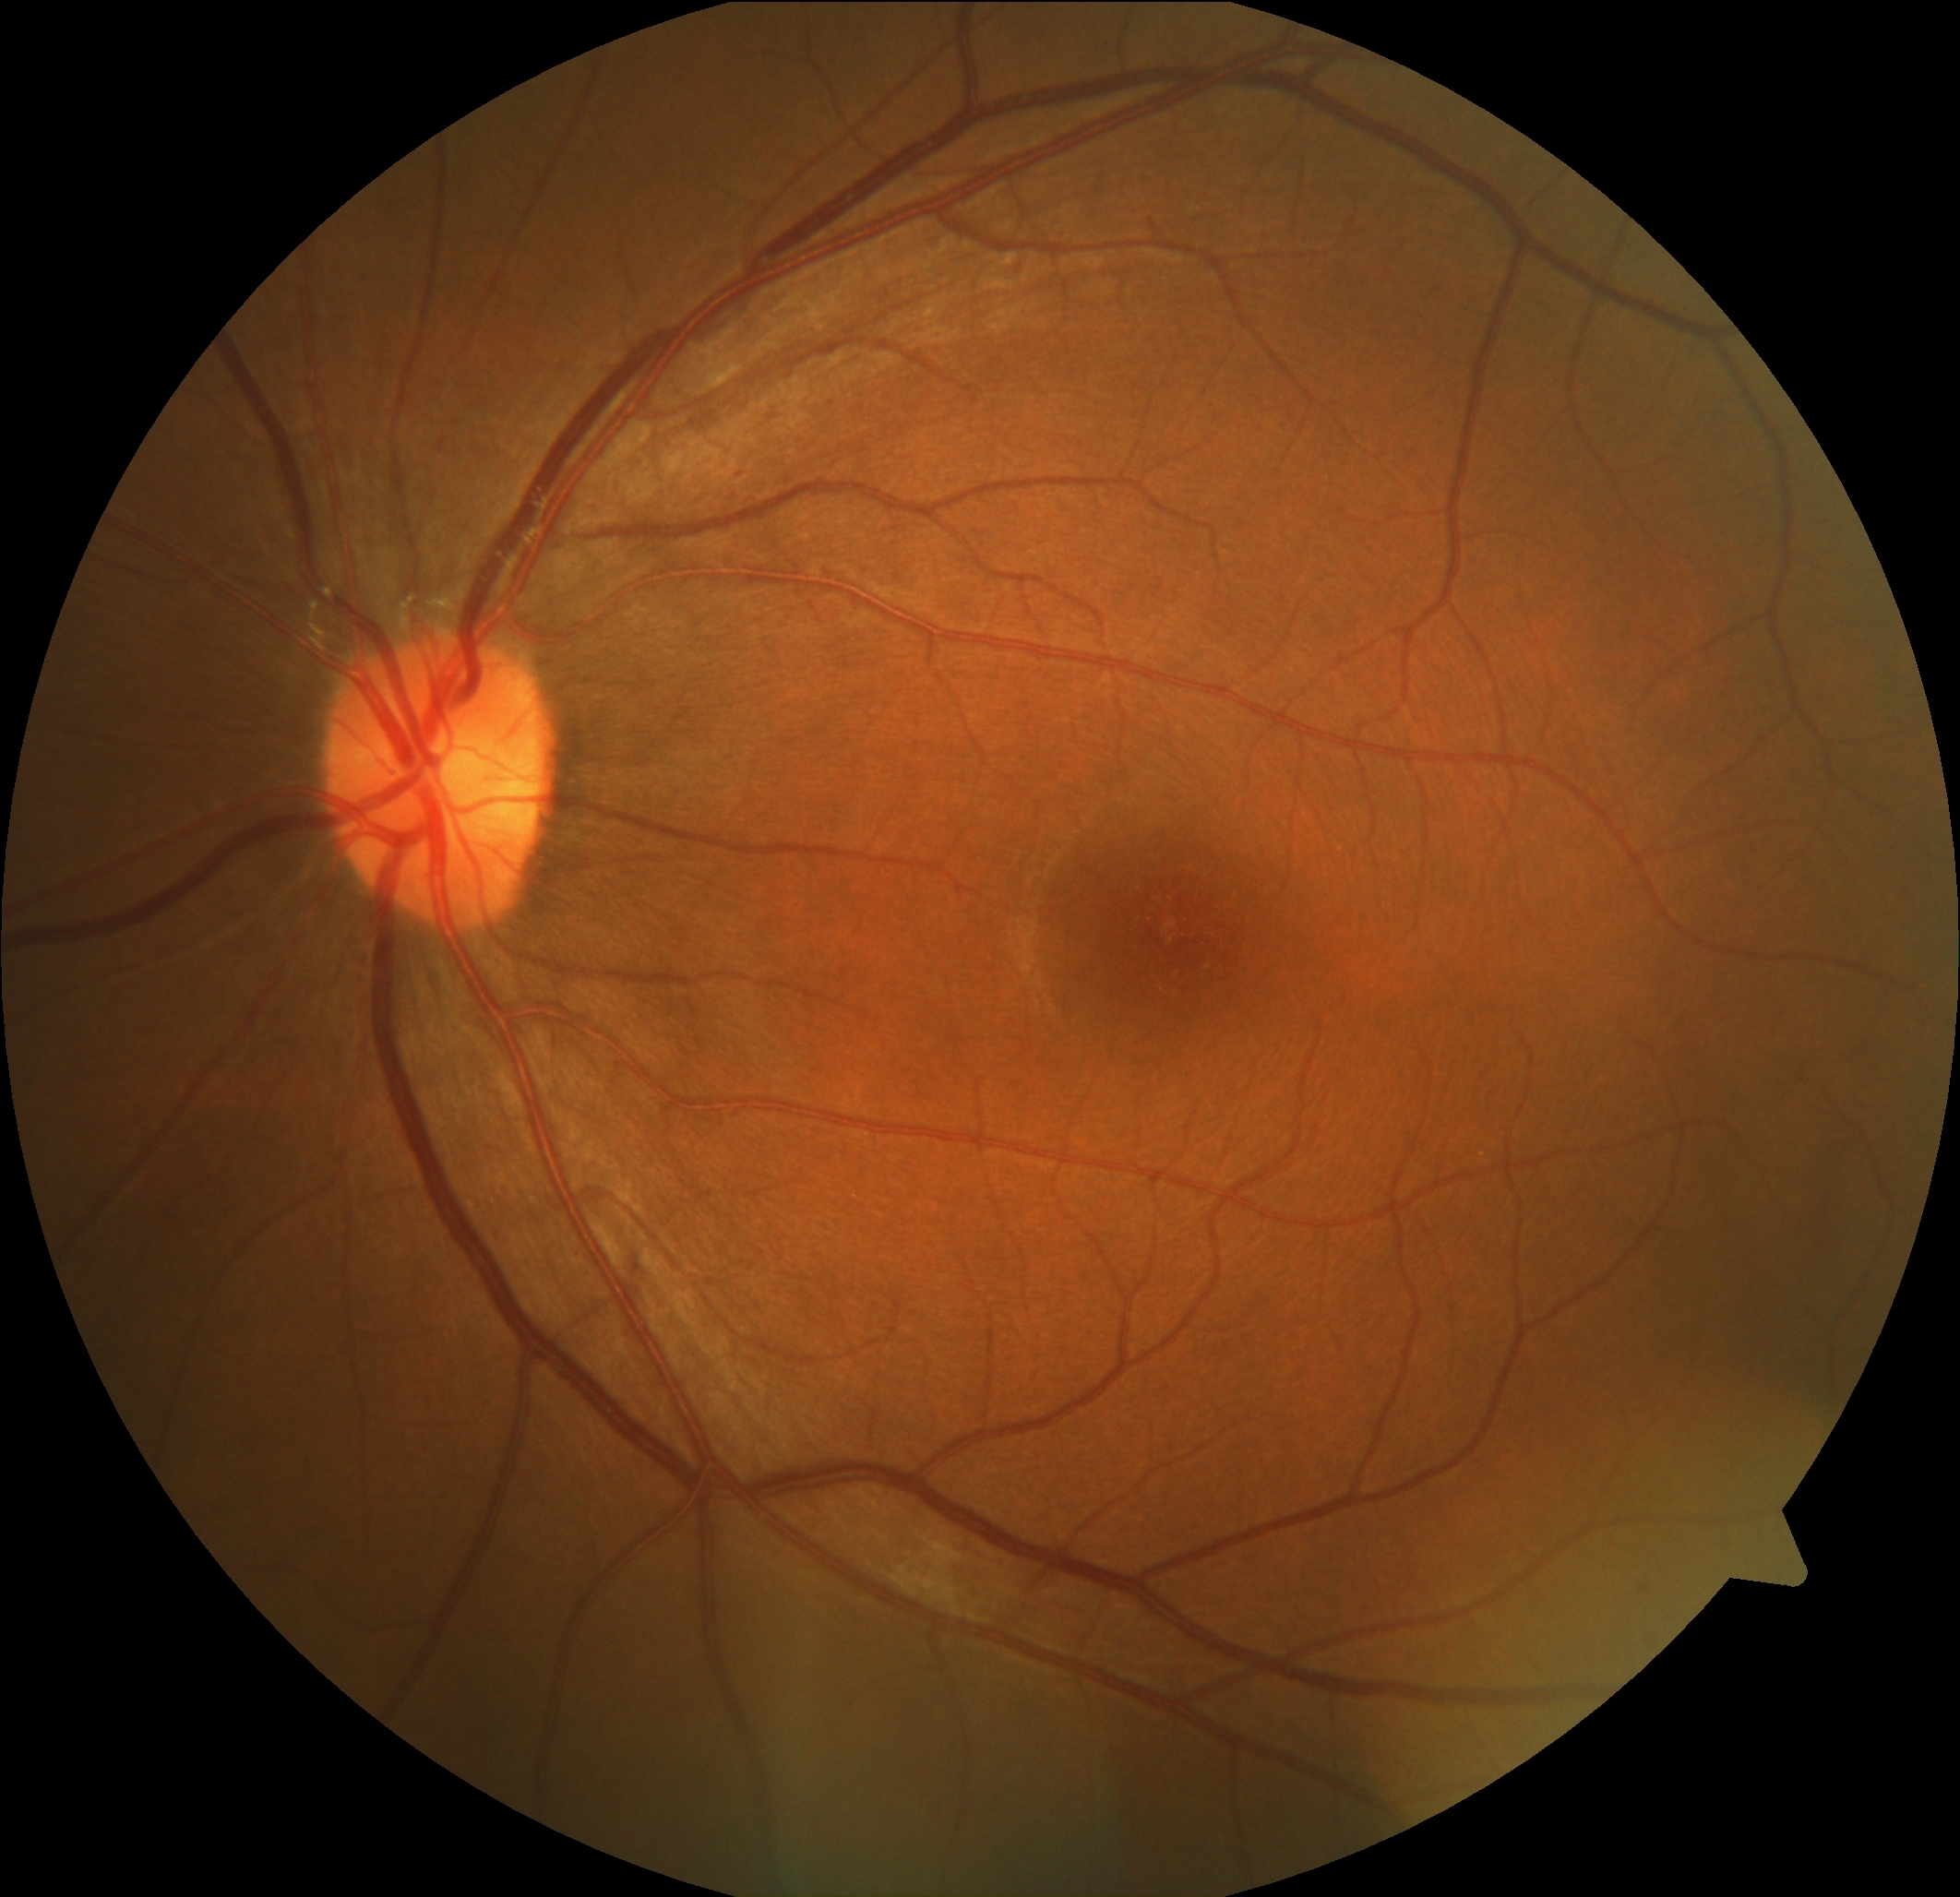 DR stage = 0.